1380x1382
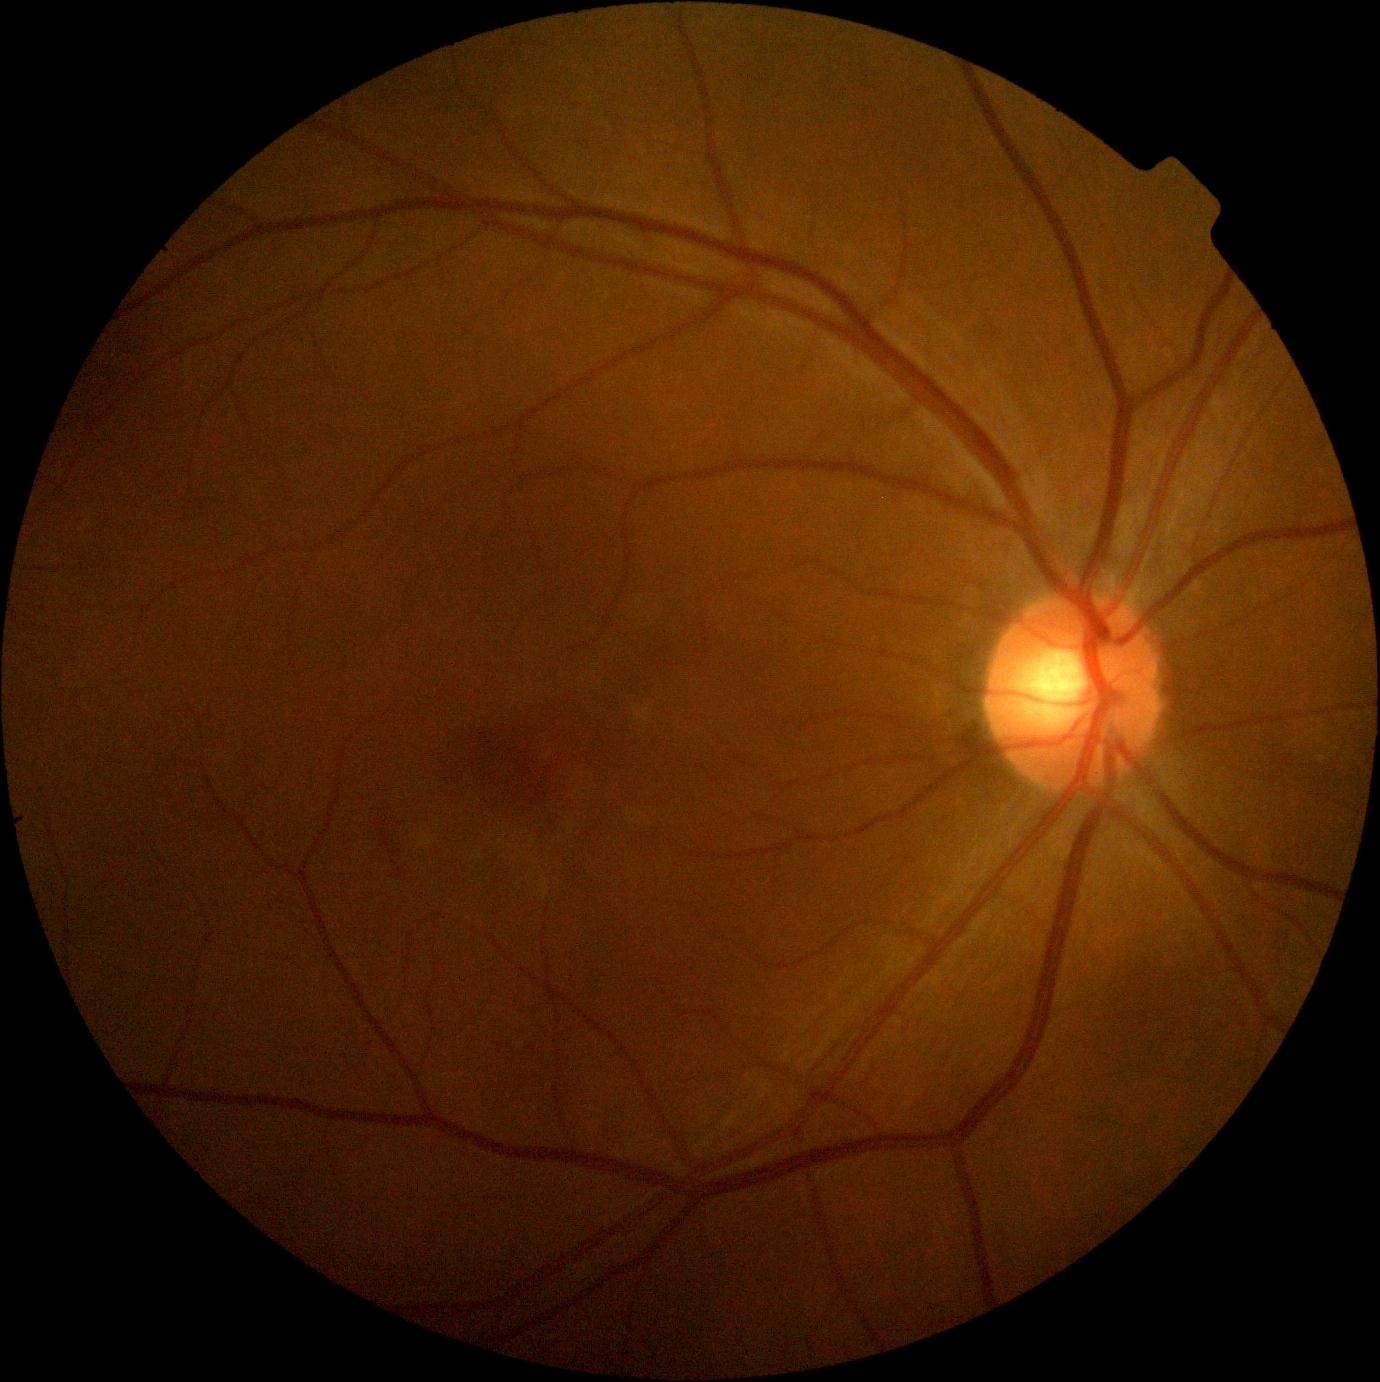 No DR findings.
DR grade: no apparent retinopathy (0).